Wide-field fundus photograph from neonatal ROP screening:
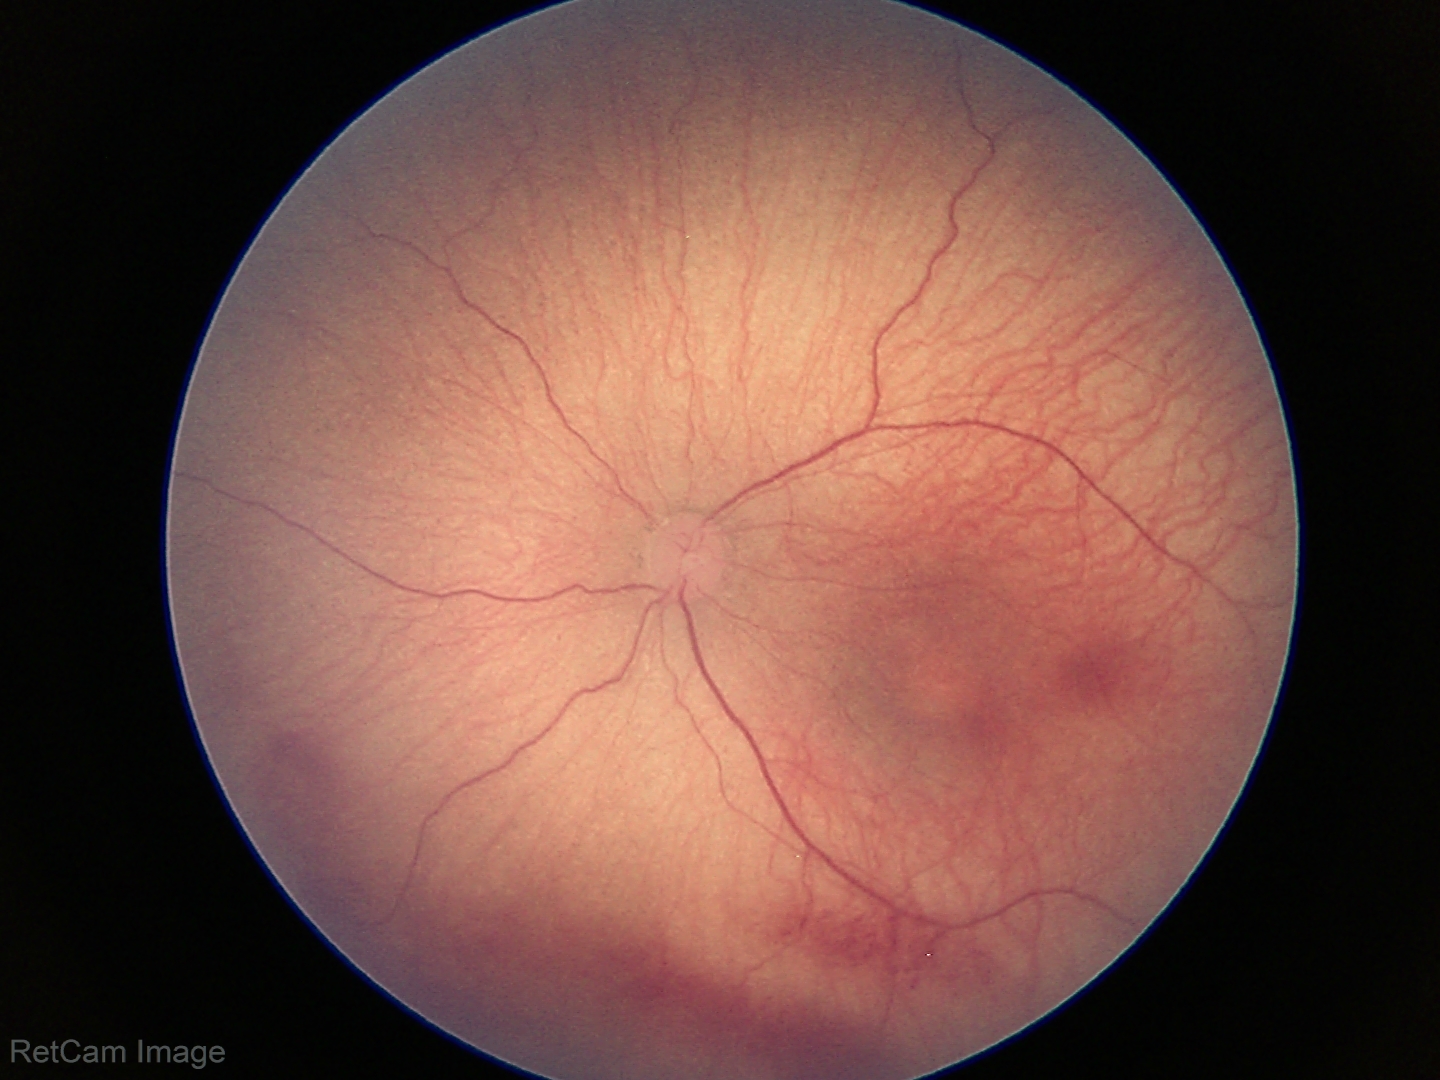
Without plus disease.
Examination diagnosed as retinopathy of prematurity (ROP) stage 1.